2048x1536; 45° field of view; CFP: 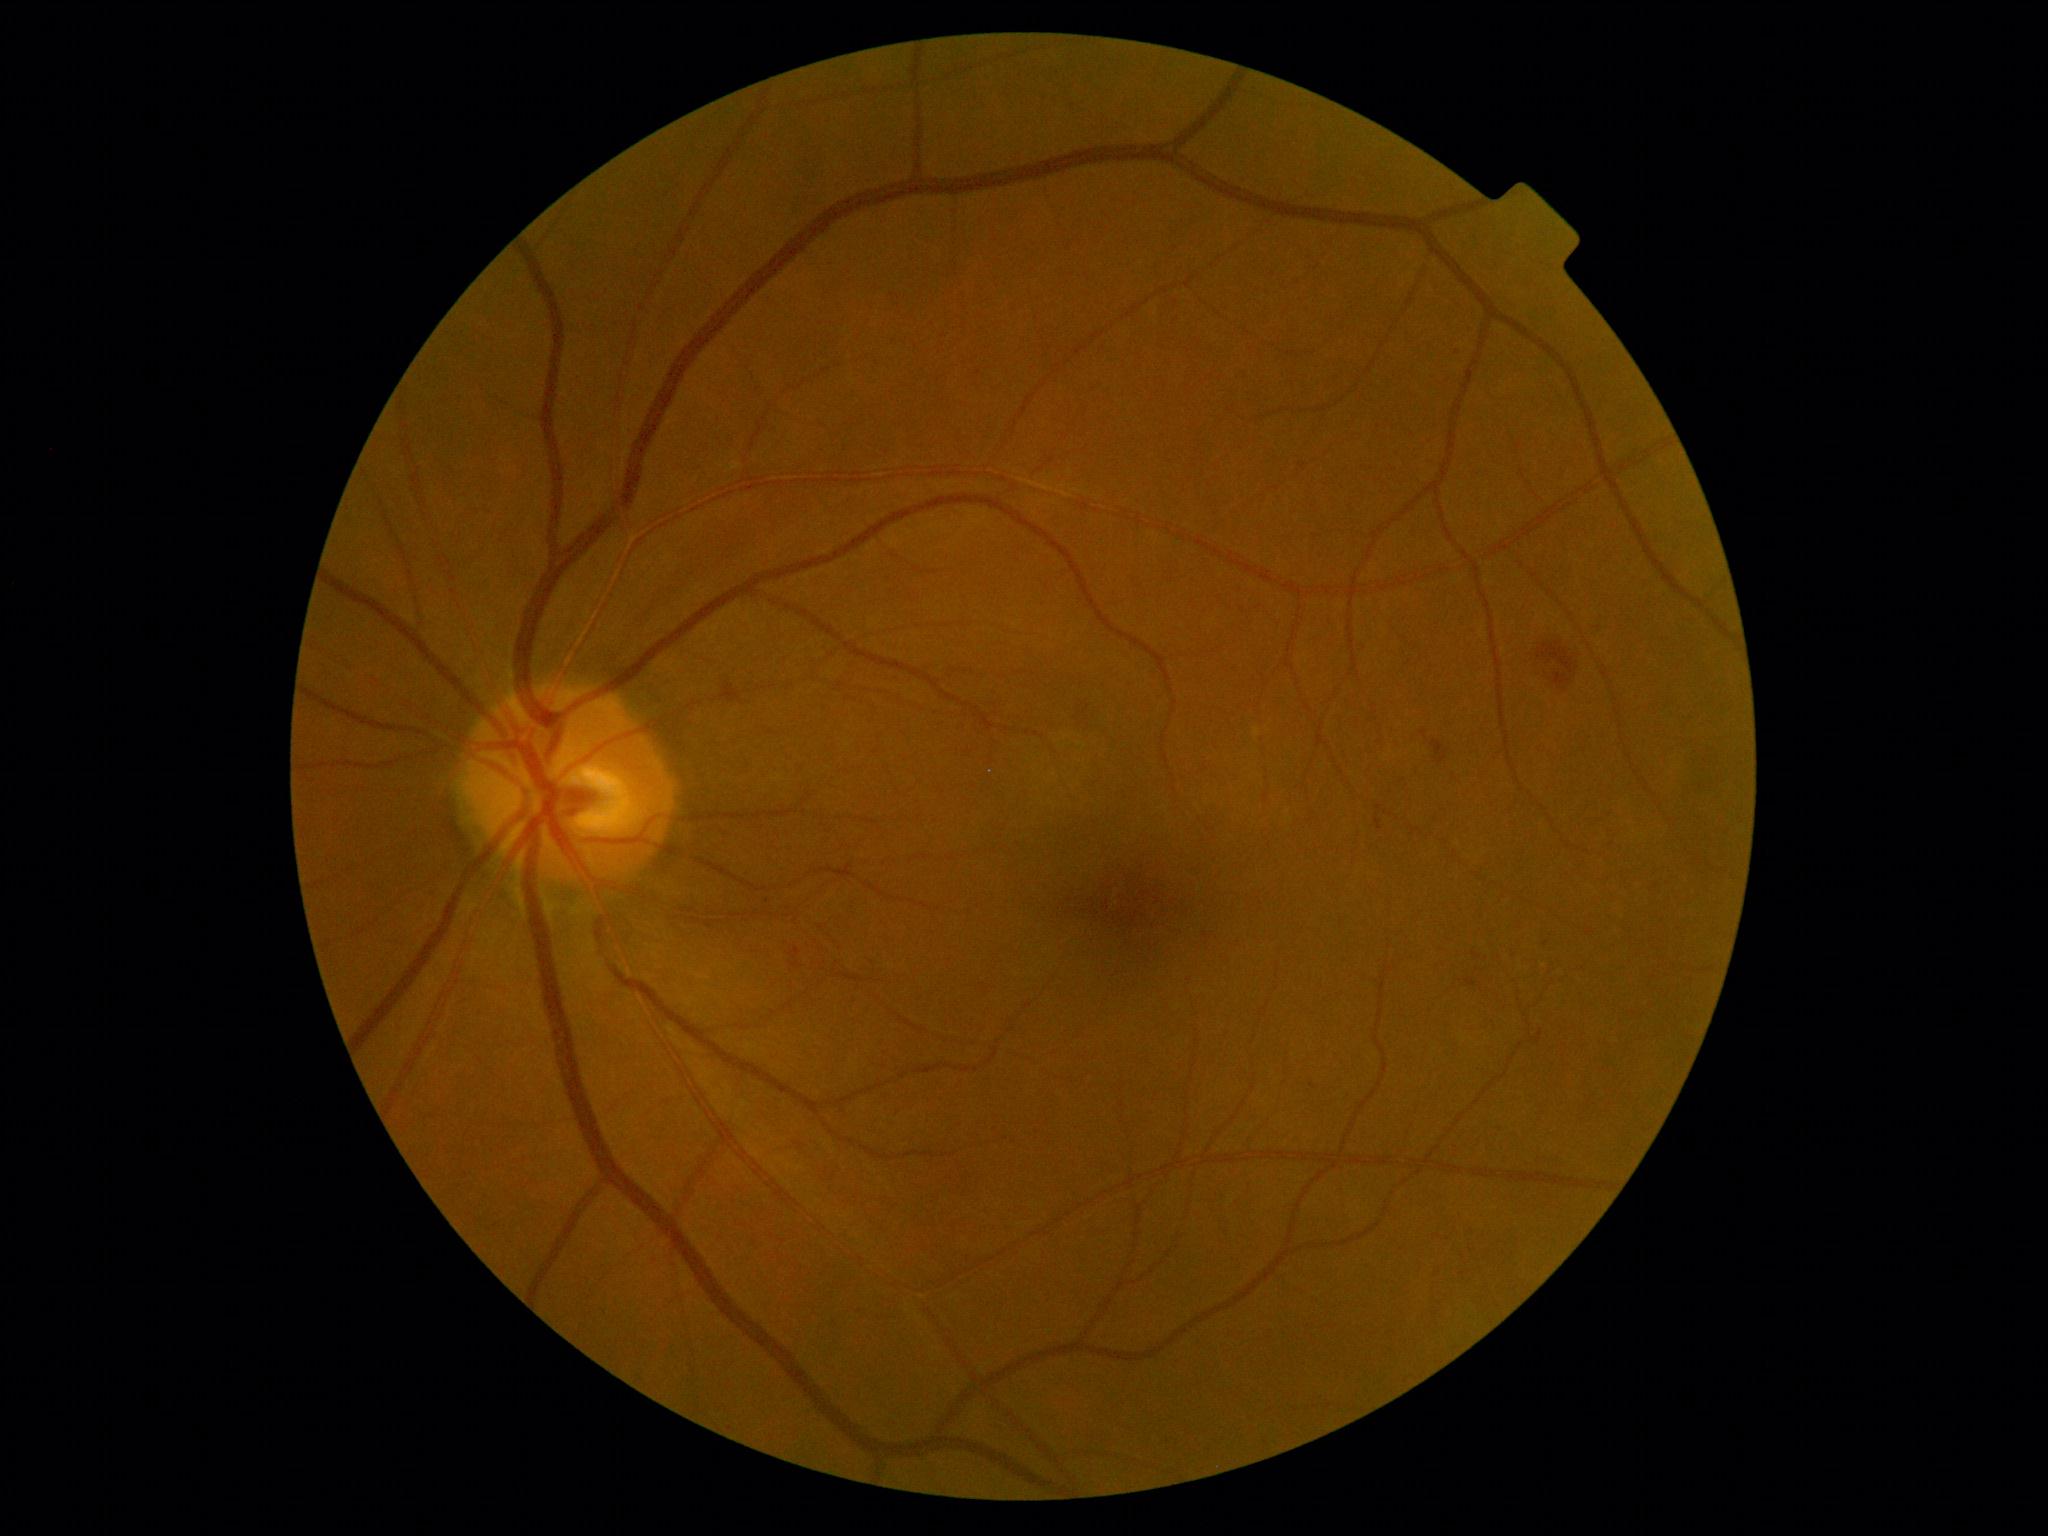 Diabetic retinopathy (DR): grade 2
Detected lesions:
• hemorrhages (HEs): rect(1431, 742, 1449, 765), rect(1555, 673, 1572, 687), rect(1538, 643, 1574, 673)
• soft exudates (SEs): absent
• hard exudates (EXs): absent
• microaneurysms (MAs): rect(1466, 978, 1477, 987), rect(1376, 819, 1383, 831), rect(790, 948, 800, 960)
• Small MAs near (1424, 735), (1476, 957), (1313, 1086), (1517, 950), (767, 902), (1599, 628), (1547, 945)